Nonmydriatic fundus photograph:
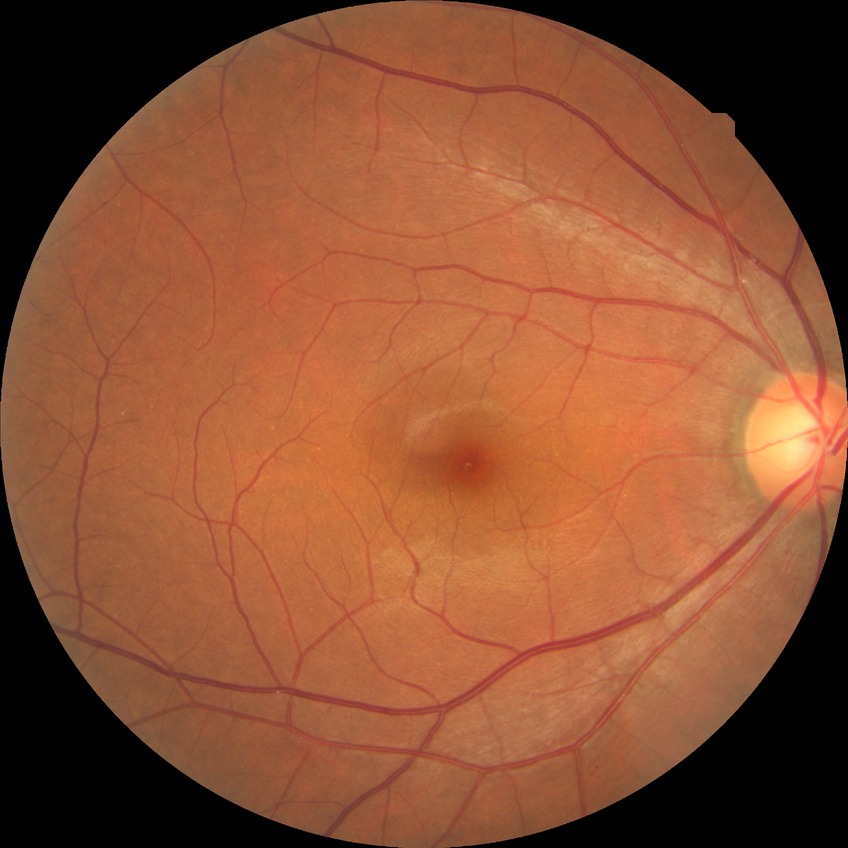 diabetic retinopathy grade: no diabetic retinopathy